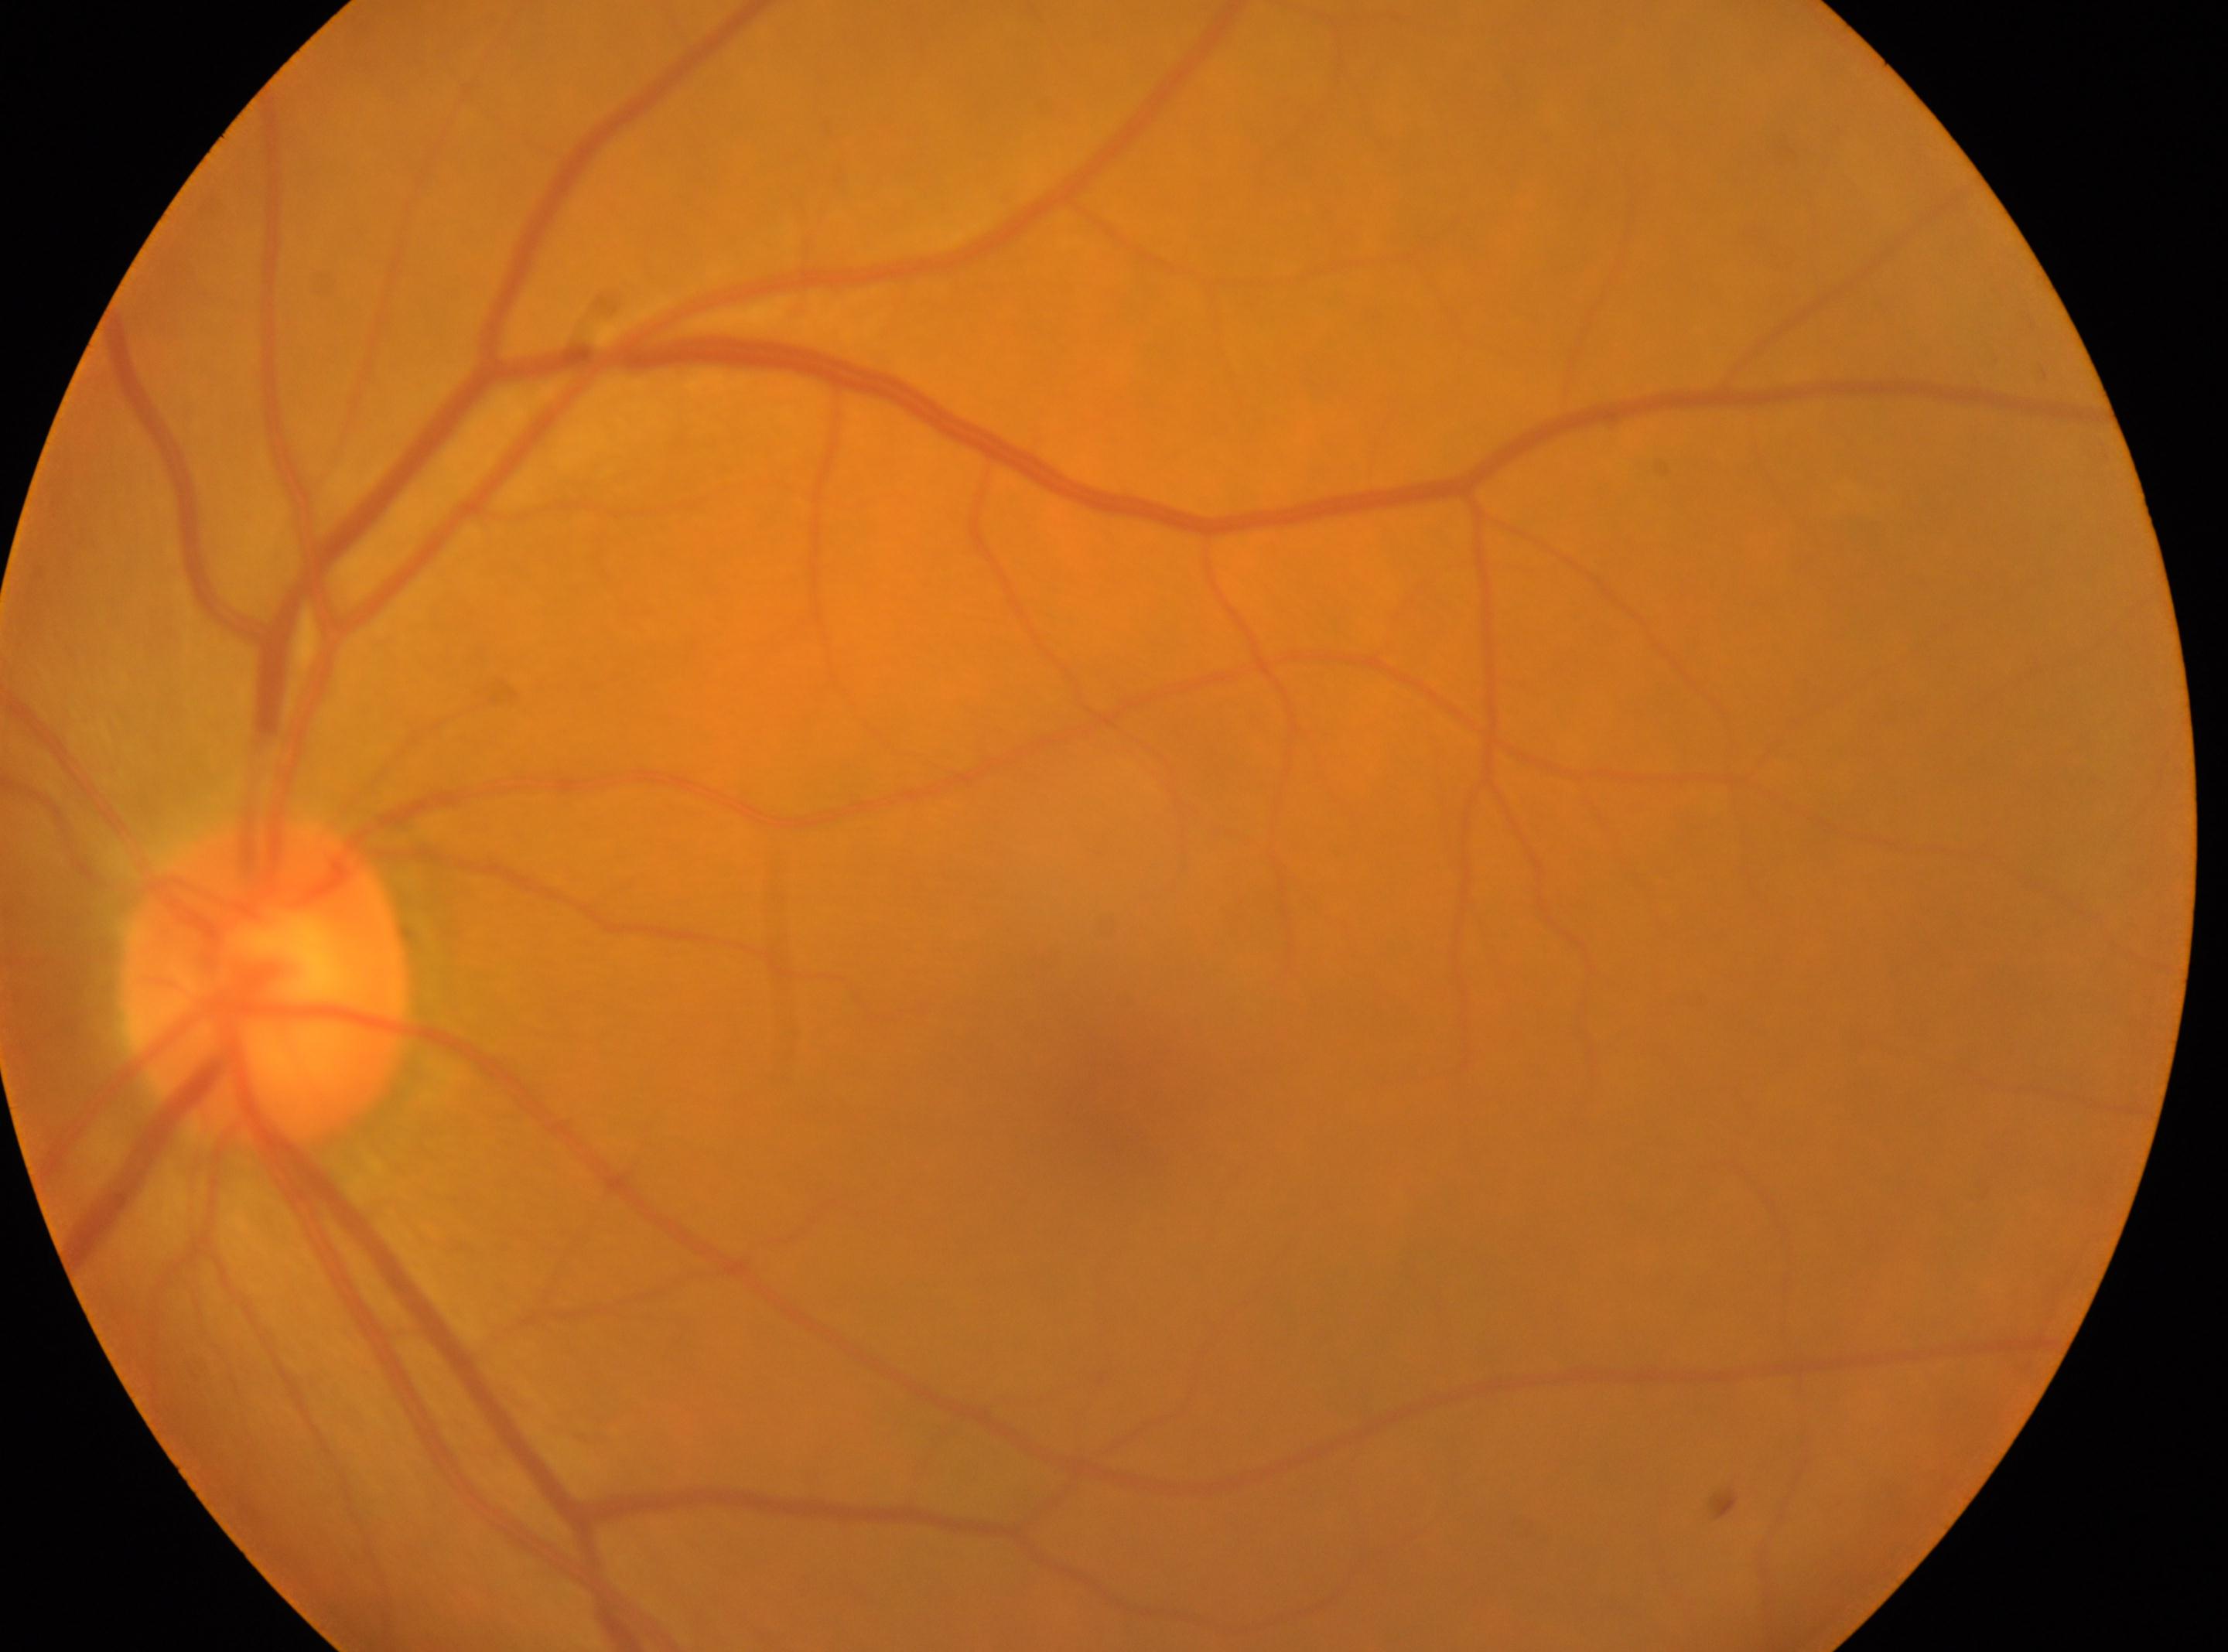 No DR findings. The macula center is at (x=1120, y=1087). Optic disc: (x=268, y=985). This is the oculus sinister. DR stage: grade 0 (no apparent retinopathy) — no visible signs of diabetic retinopathy.